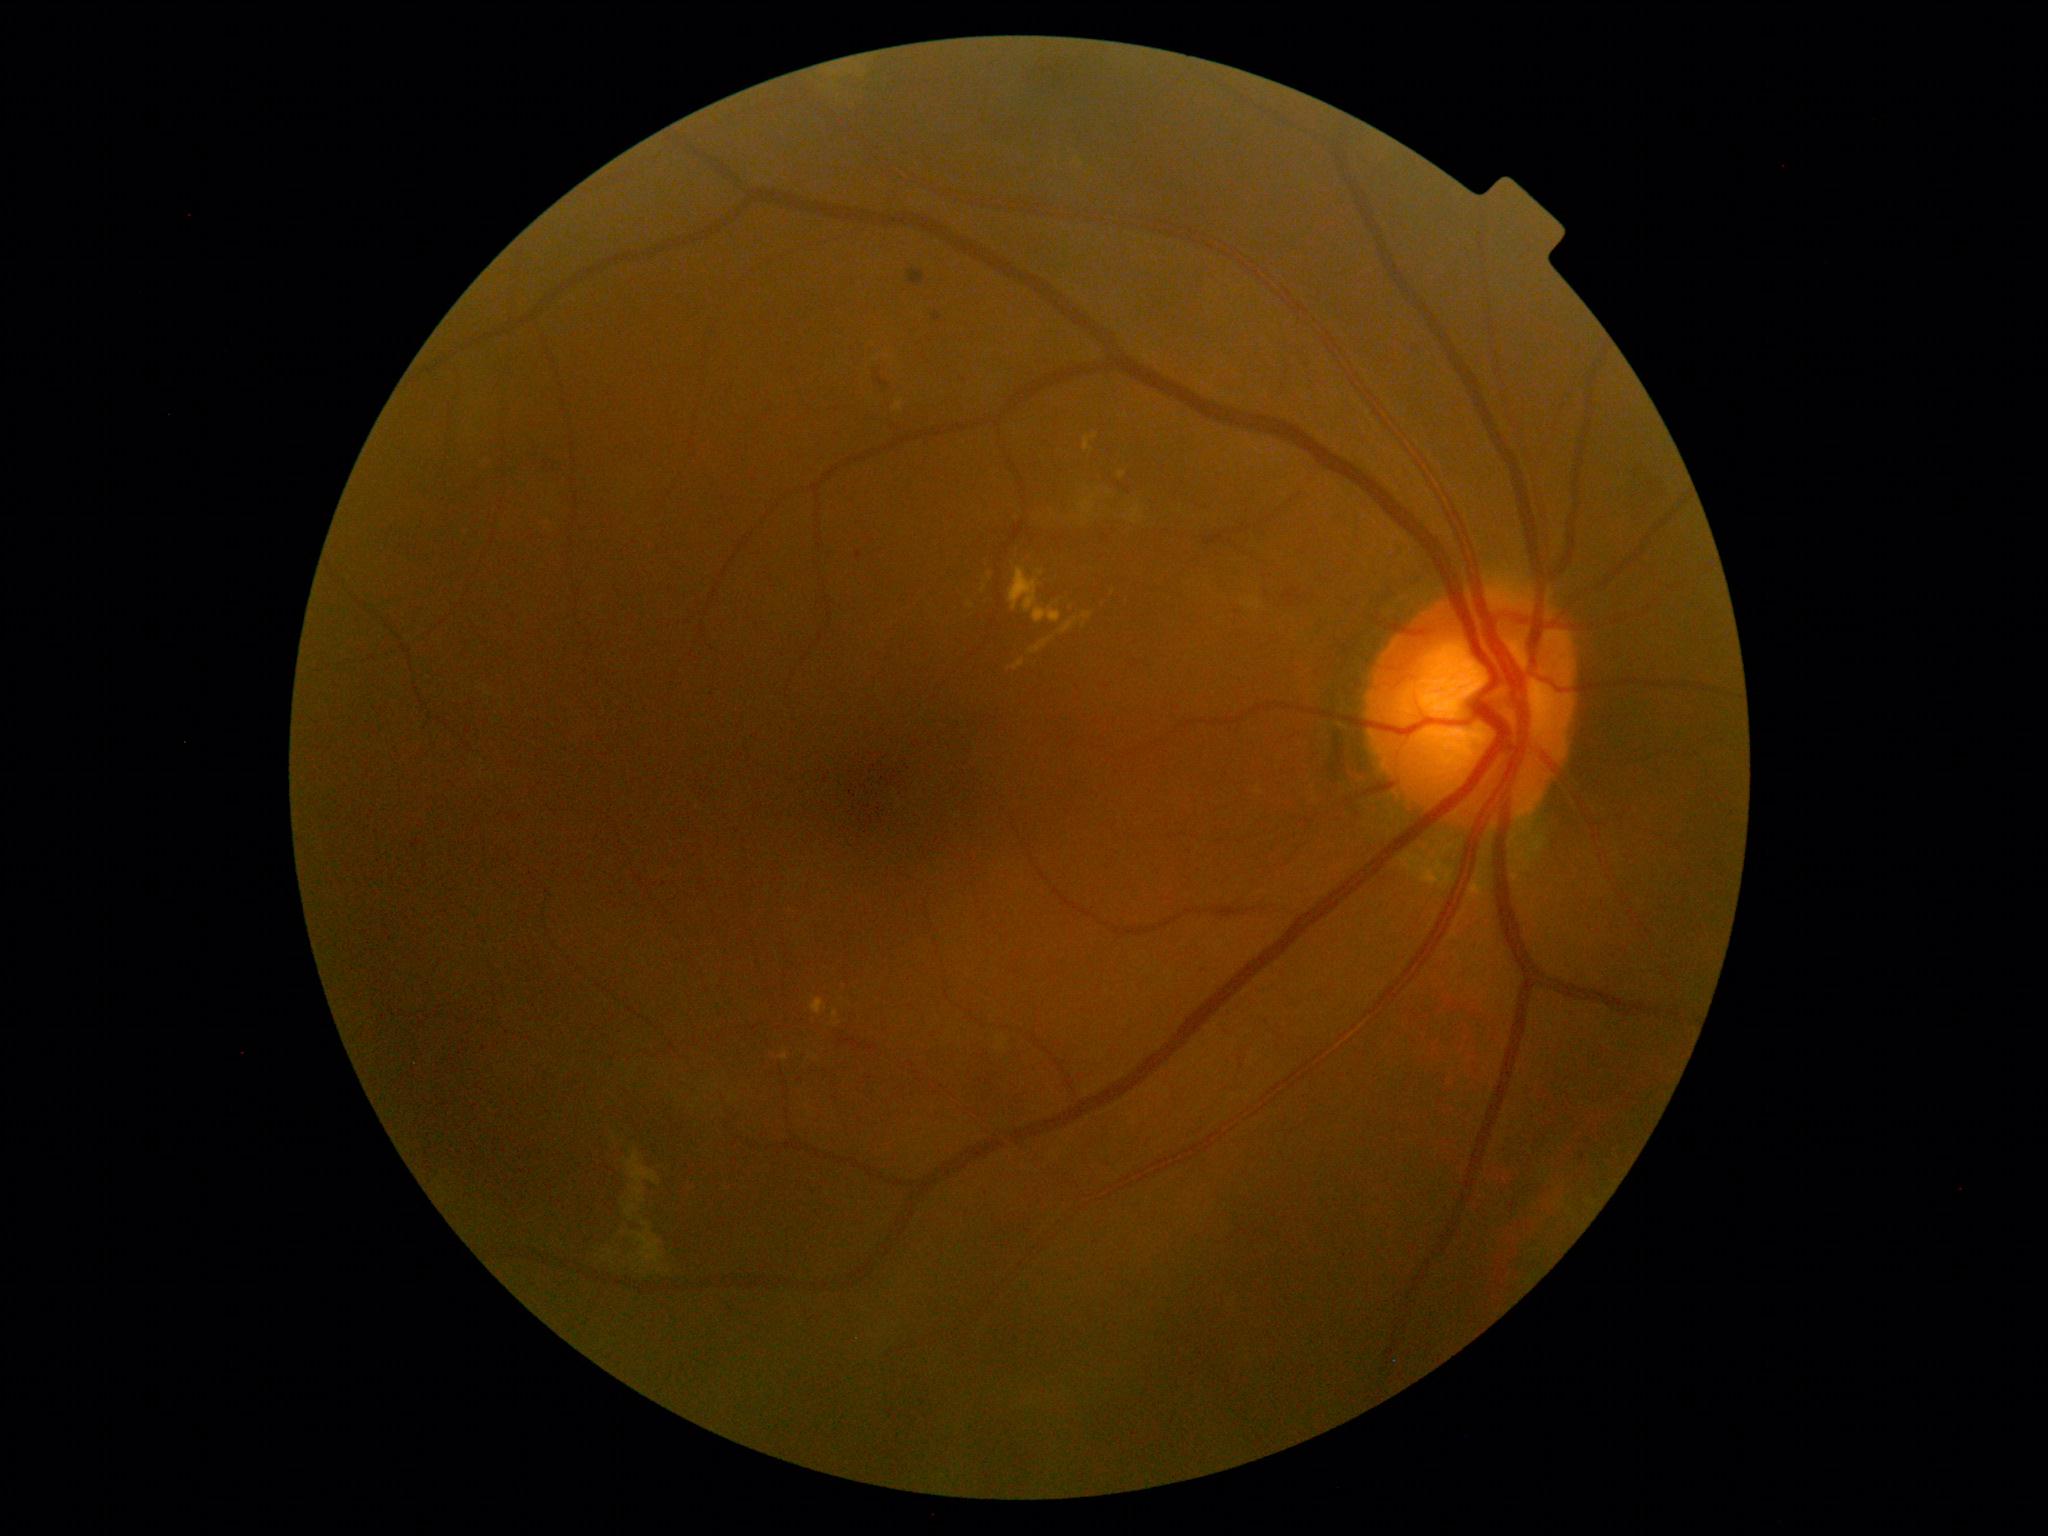 DR stage is 2/4
Selected lesions:
SEs (continued): (x1=627, y1=1152, x2=658, y2=1185) | (x1=634, y1=1187, x2=645, y2=1203) | (x1=615, y1=1222, x2=631, y2=1242) | (x1=625, y1=1205, x2=637, y2=1222) | (x1=642, y1=1222, x2=650, y2=1226) | (x1=634, y1=1229, x2=662, y2=1263)
Smaller SEs around Point(603, 1258) | Point(610, 1253) | Point(660, 1271) | Point(644, 1264) | Point(639, 1265)
HEs: (x1=539, y1=455, x2=565, y2=470) | (x1=840, y1=1037, x2=863, y2=1050) | (x1=876, y1=378, x2=890, y2=388) | (x1=1509, y1=1202, x2=1517, y2=1215) | (x1=867, y1=1046, x2=877, y2=1051) | (x1=908, y1=271, x2=926, y2=287) | (x1=933, y1=314, x2=941, y2=322) | (x1=856, y1=551, x2=863, y2=560) | (x1=1283, y1=588, x2=1299, y2=607)
Smaller HEs around Point(1583, 1157) | Point(877, 373) | Point(800, 1080)
MAs: absent
EXs (continued): (x1=894, y1=401, x2=904, y2=411) | (x1=780, y1=1052, x2=788, y2=1060) | (x1=811, y1=999, x2=827, y2=1014) | (x1=833, y1=1010, x2=838, y2=1019) | (x1=1009, y1=568, x2=1040, y2=613) | (x1=1033, y1=607, x2=1062, y2=624) | (x1=1013, y1=660, x2=1024, y2=671) | (x1=1060, y1=618, x2=1079, y2=634) | (x1=1083, y1=613, x2=1093, y2=620) | (x1=1084, y1=434, x2=1099, y2=452) | (x1=1029, y1=640, x2=1052, y2=654)
Smaller EXs around Point(970, 606) | Point(837, 1024) | Point(1113, 592) | Point(1122, 475) | Point(984, 589) | Point(1084, 625) | Point(1040, 573)